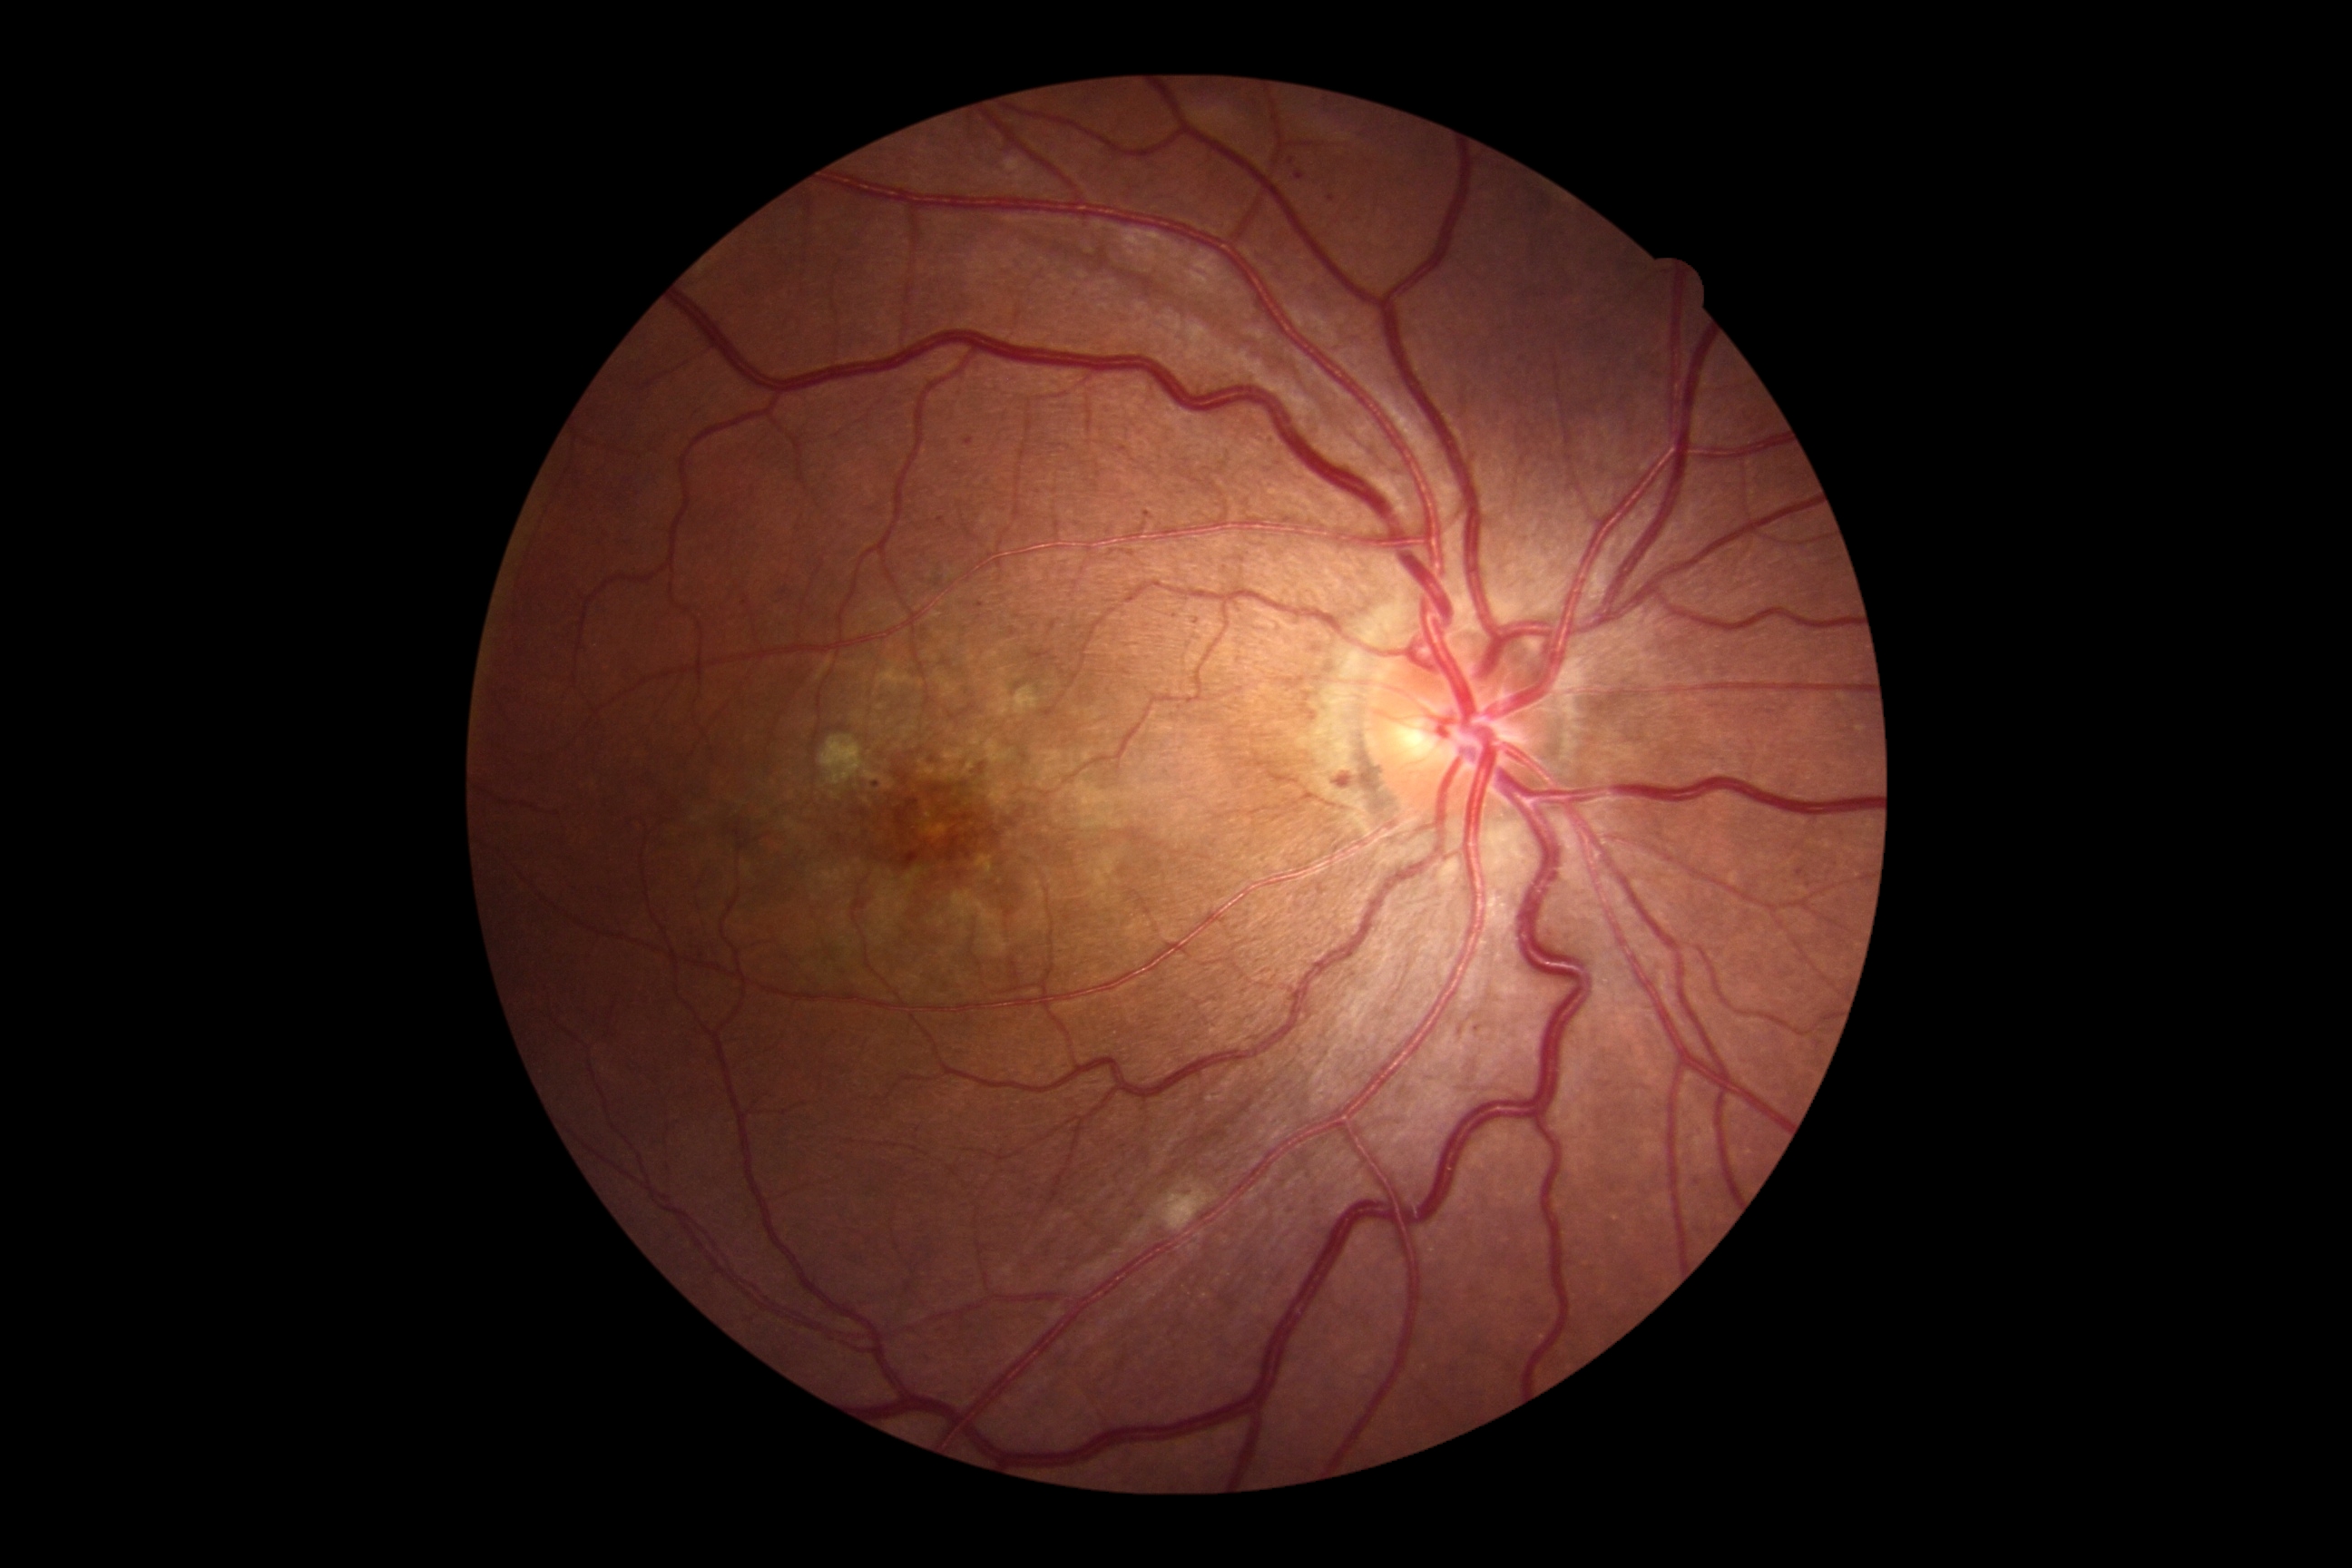

Diabetic retinopathy severity: grade 2 (moderate NPDR).